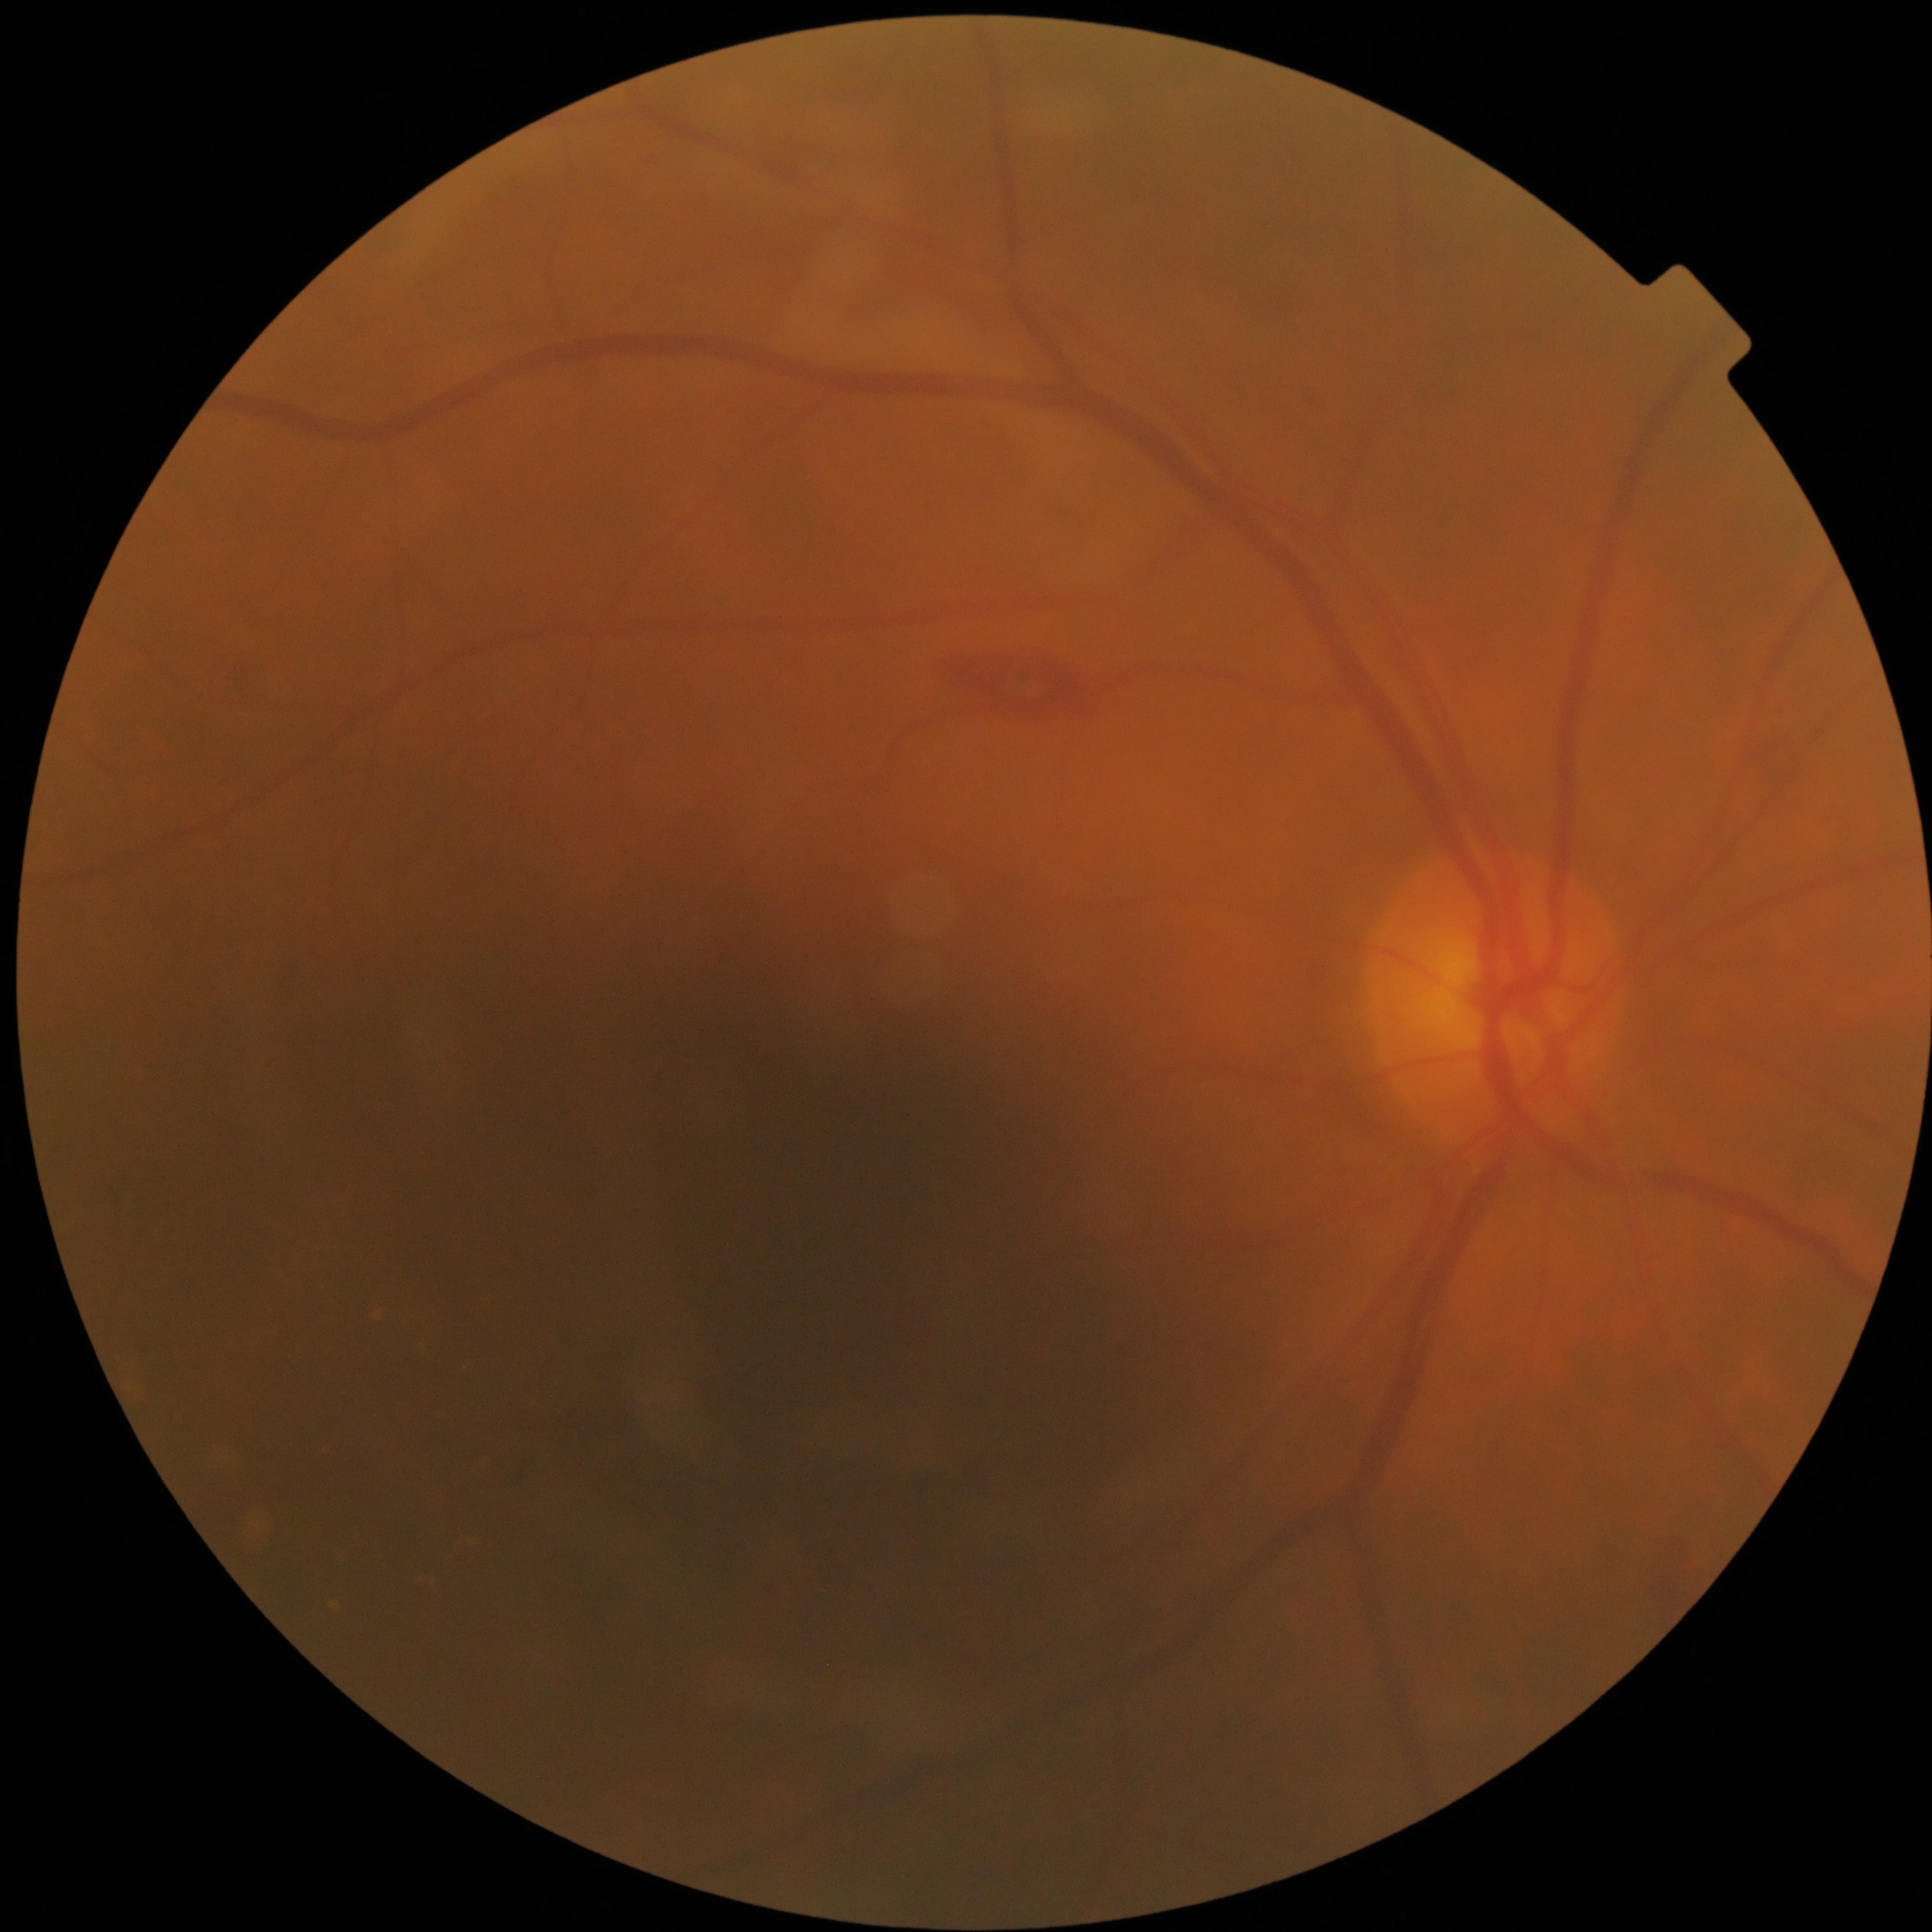
DR = moderate NPDR (grade 2)